Acquired with a Remidio FOP fundus camera
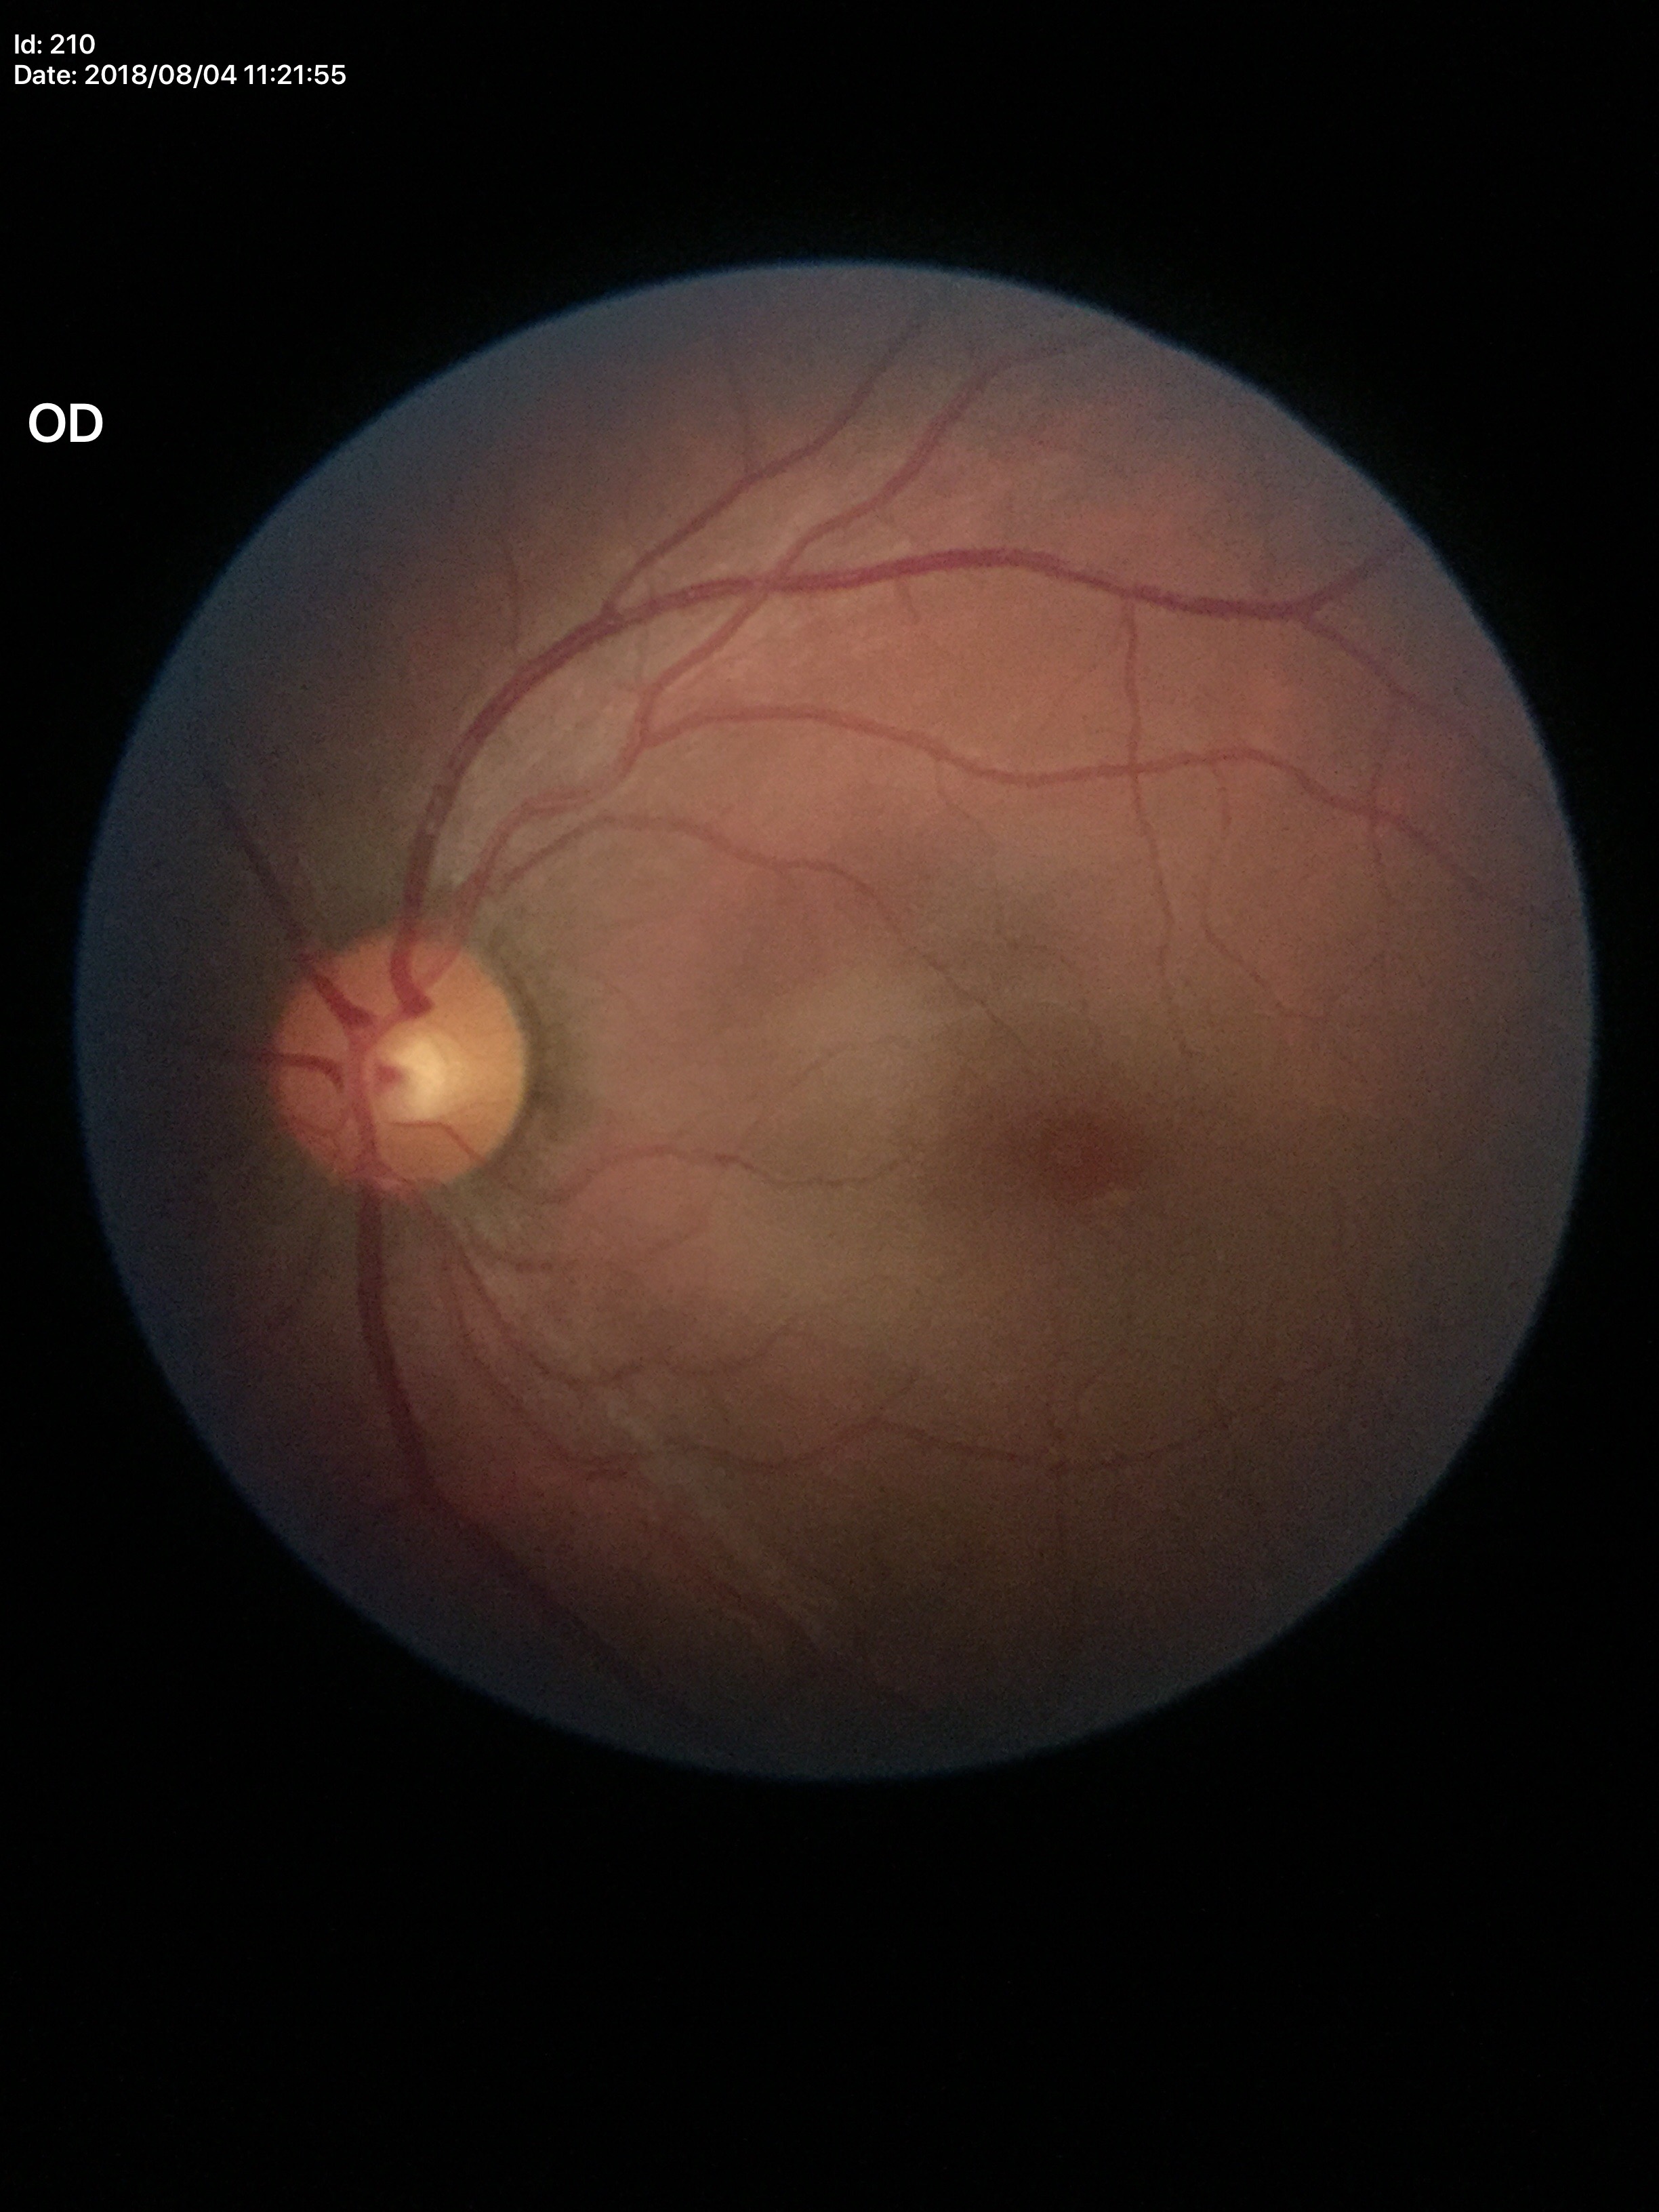
{
  "hcdr": "0.55",
  "vcdr": "0.49",
  "glaucoma_decision": "no suspicious findings (5/5 ophthalmologists in agreement)"
}